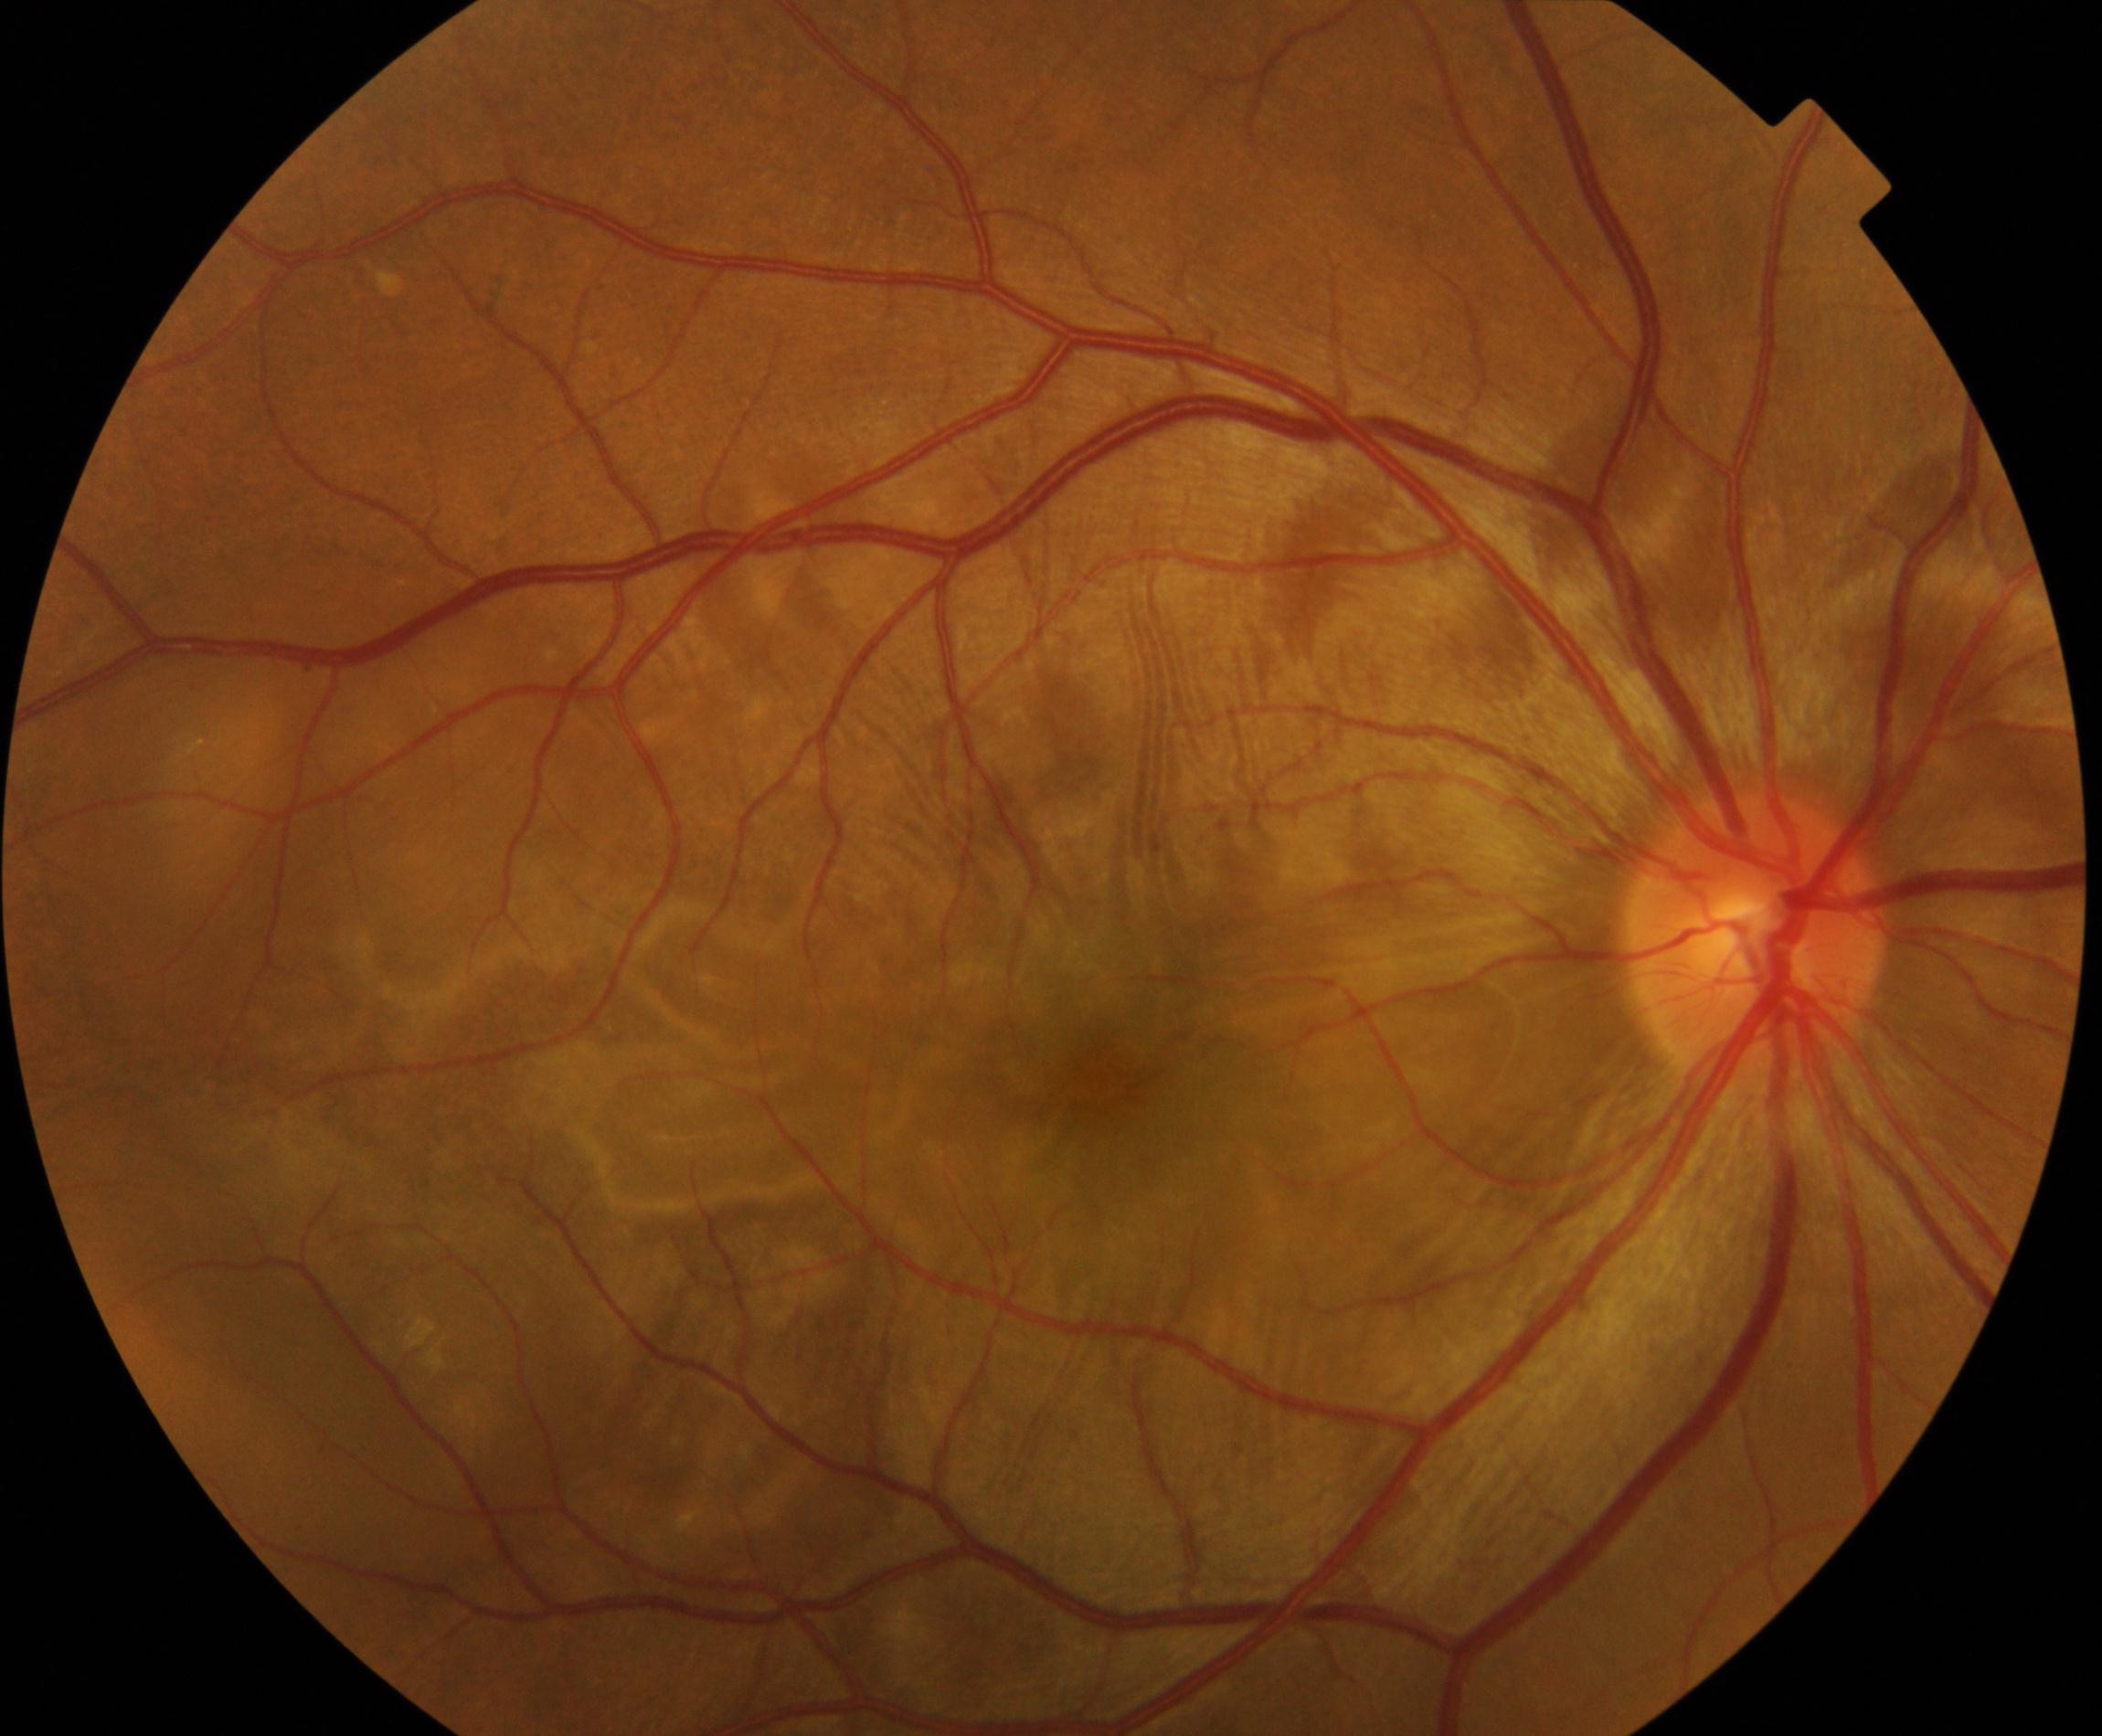 Fundus appearance consistent with Vogt-Koyanagi-Harada disease.